Fundus photo: 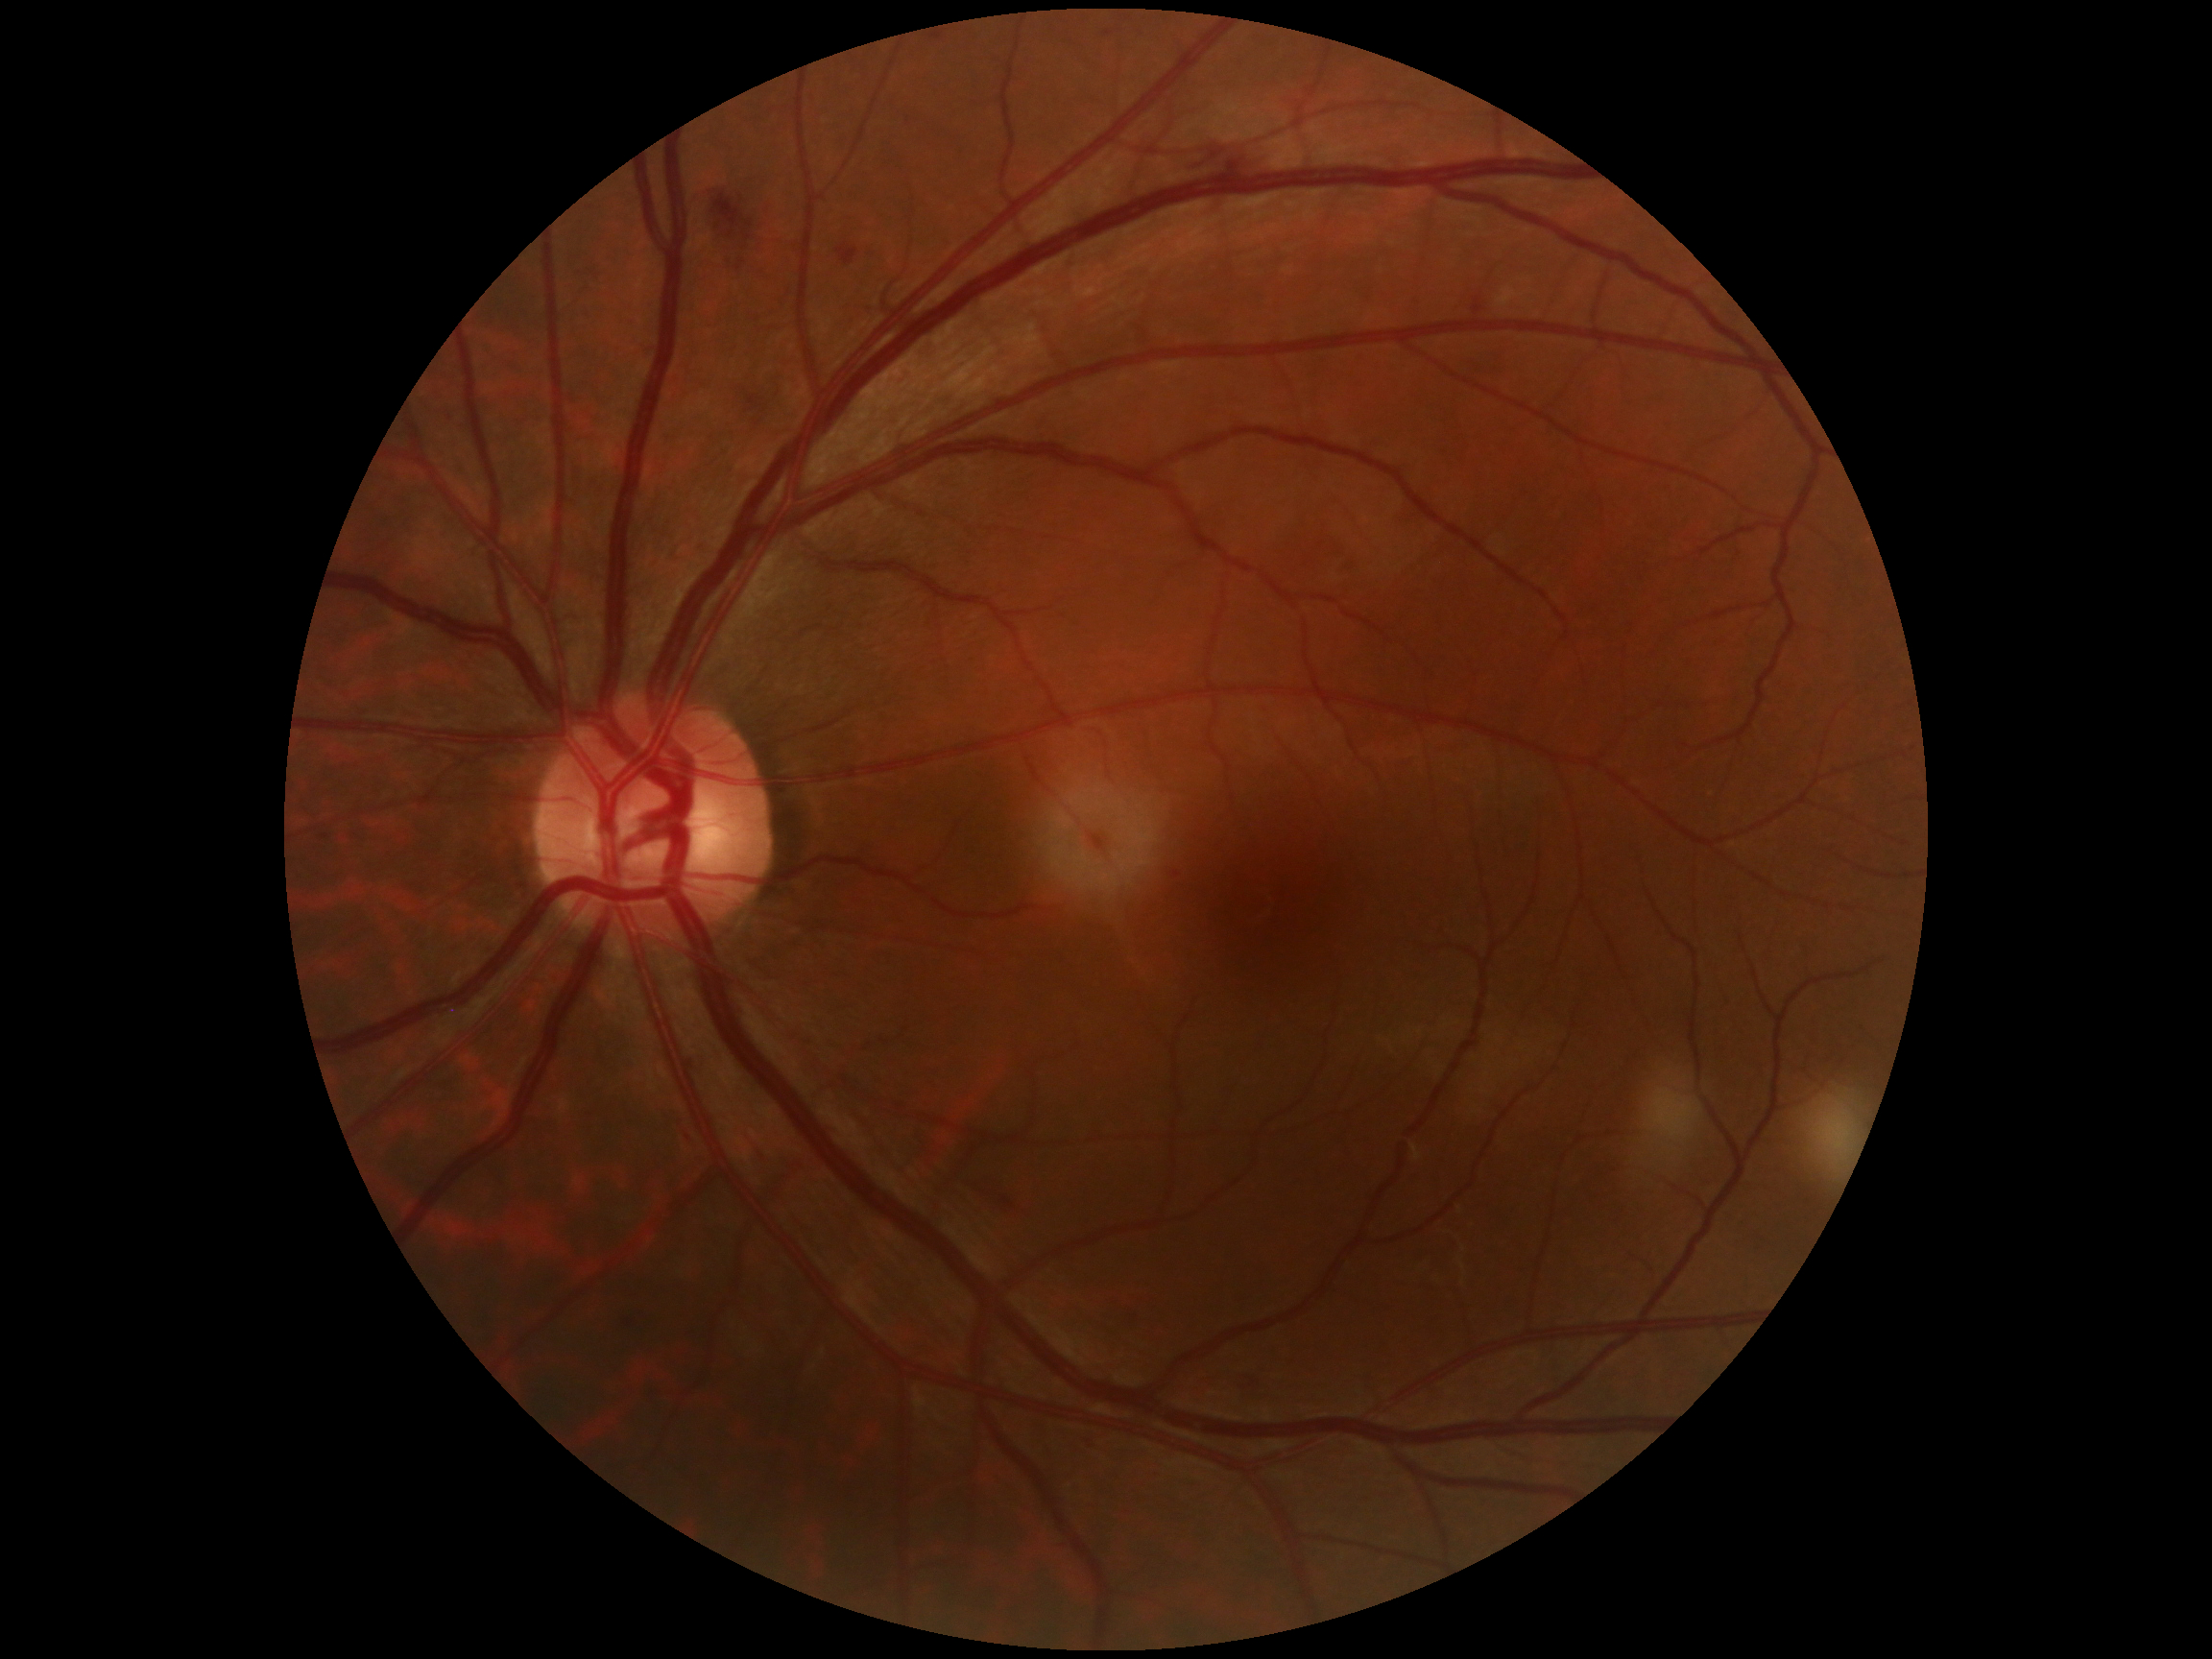

{"dr_grade": "2"}